Camera: Natus RetCam Envision (130° FOV) · infant wide-field fundus photograph — 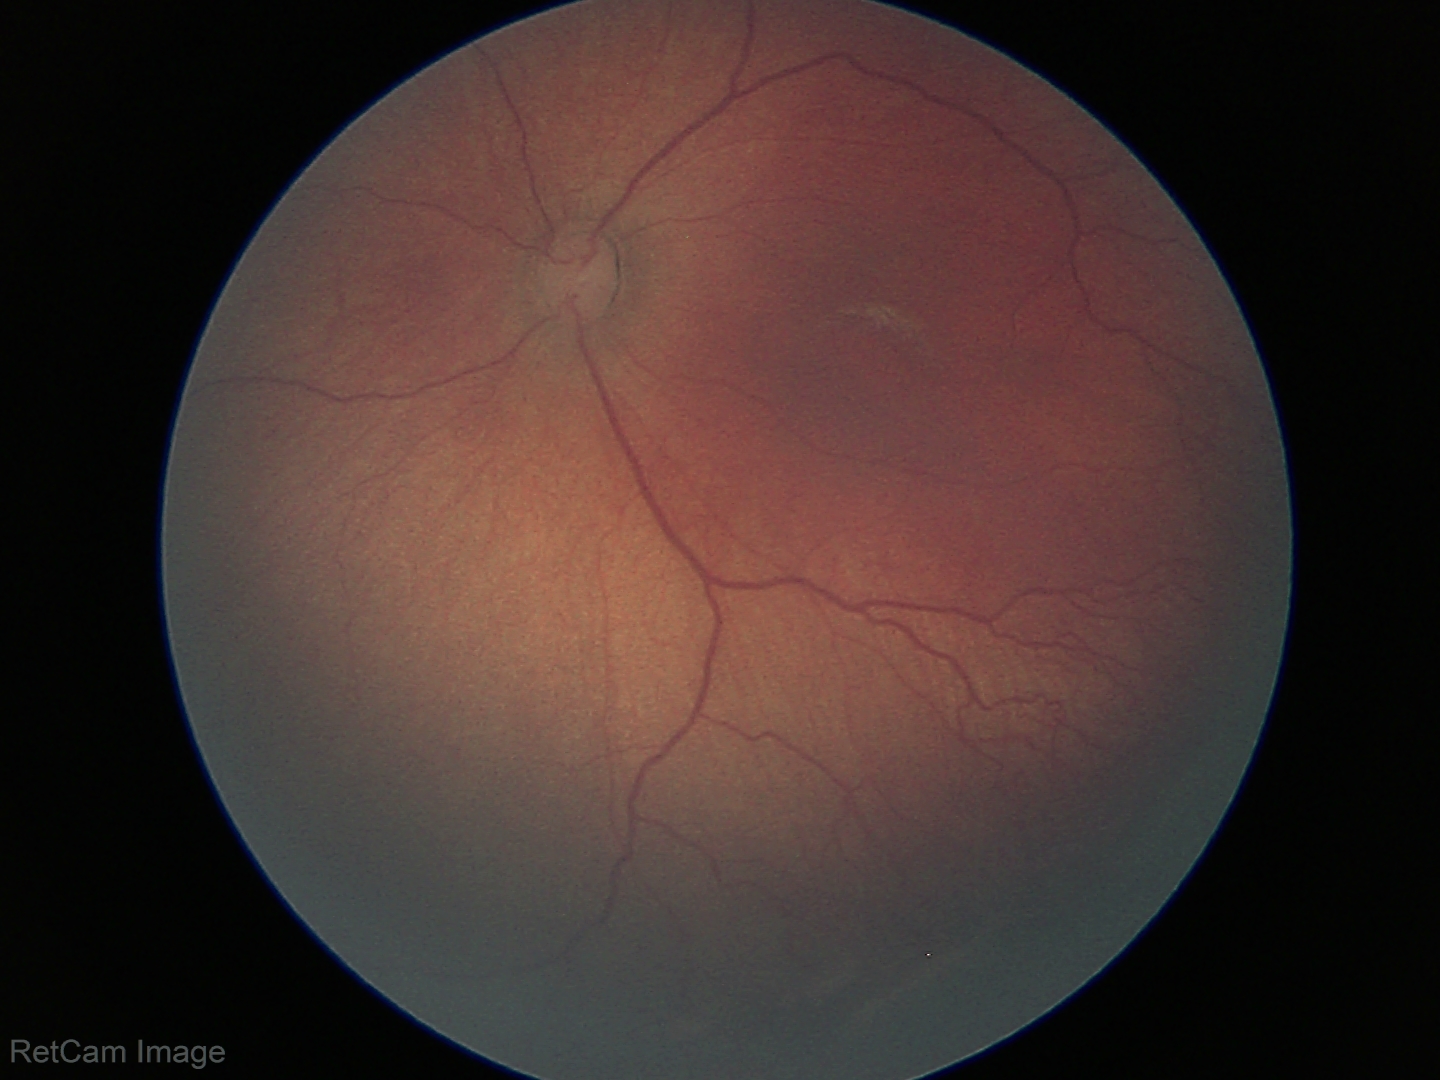

Without plus disease. Series diagnosed as retinopathy of prematurity stage 2.